1240 x 1240 pixels. Wide-field fundus photograph of an infant.
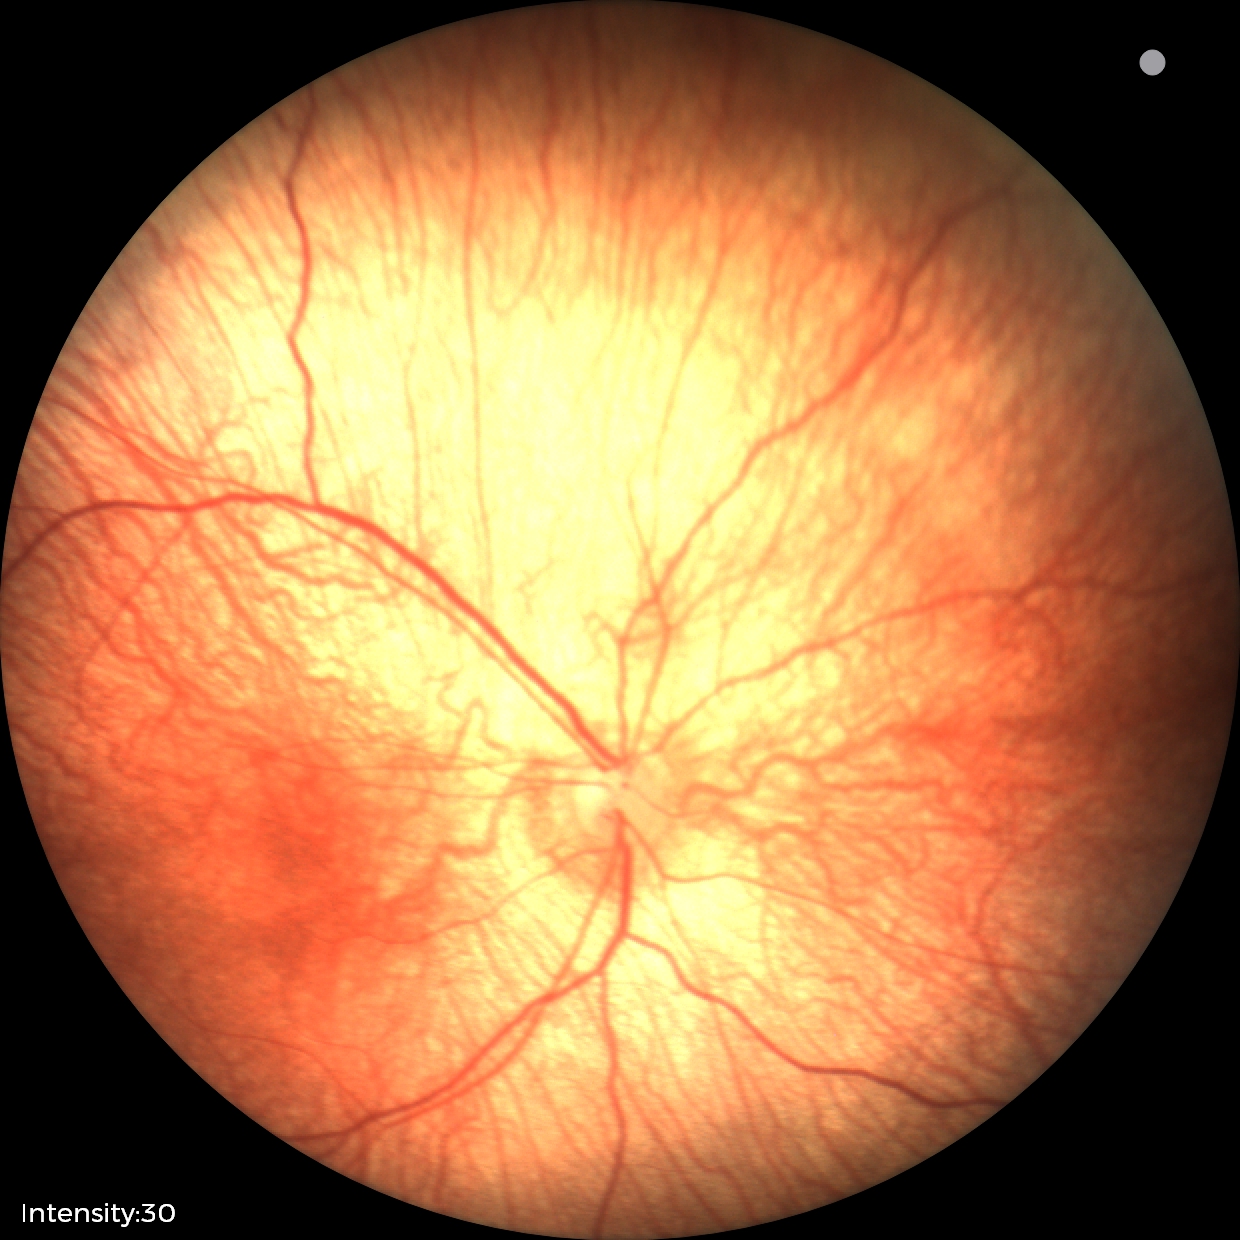

Q: What is the screening diagnosis?
A: normal fundus examination